Nonmydriatic fundus photograph, posterior pole color fundus photograph.
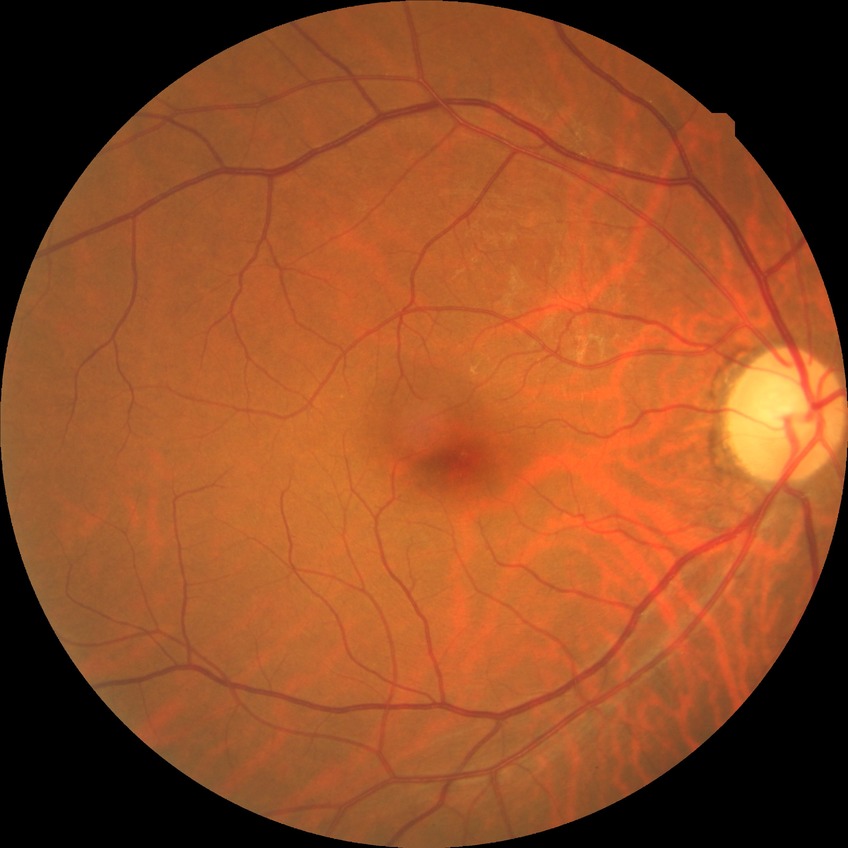
Diabetic retinopathy (DR) is NDR (no diabetic retinopathy).